FOV: 45 degrees: 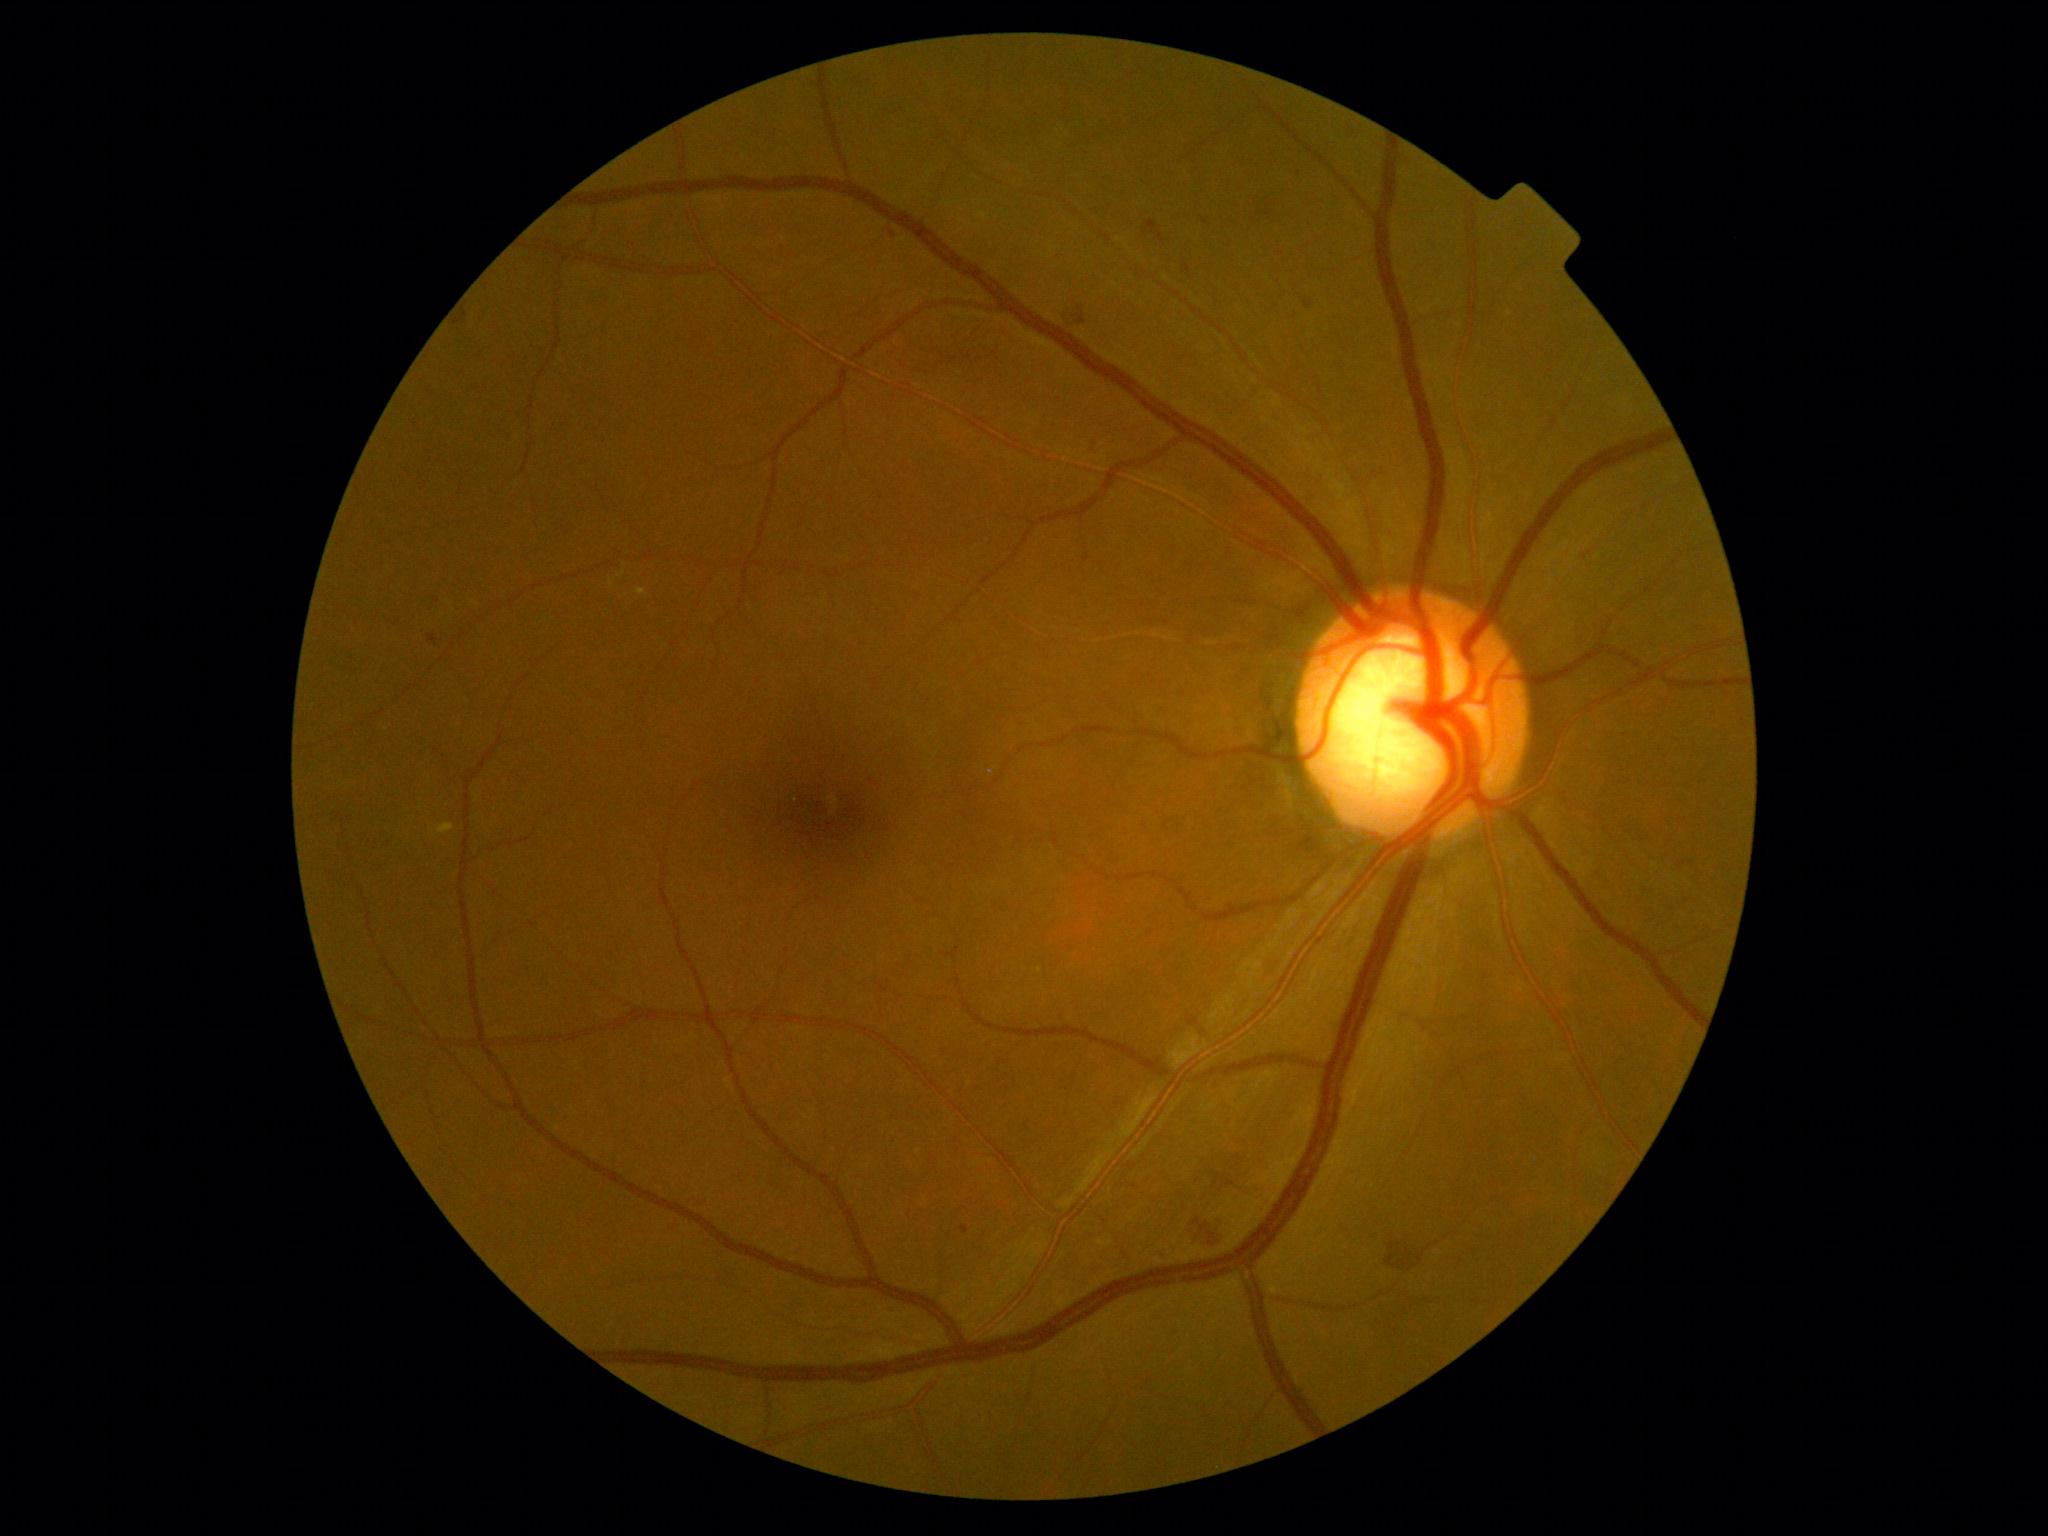 Diabetic retinopathy grade: 2.